Graded on the modified Davis scale, 45° FOV.
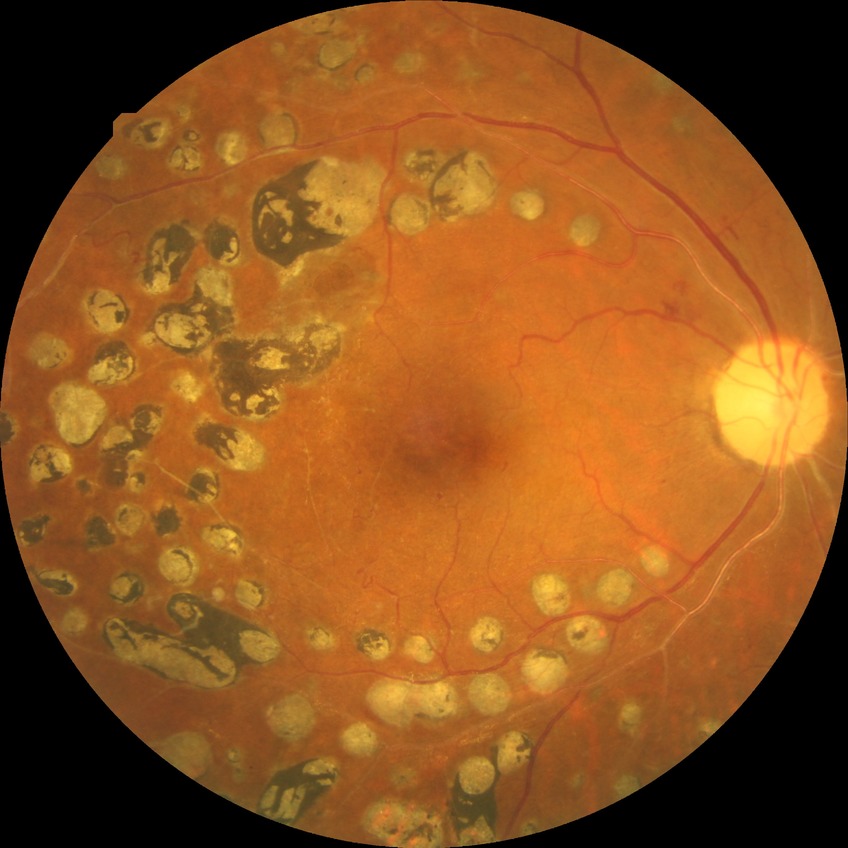

* Davis stage: PDR